45° FOV, color fundus photograph, NIDEK AFC-230 — 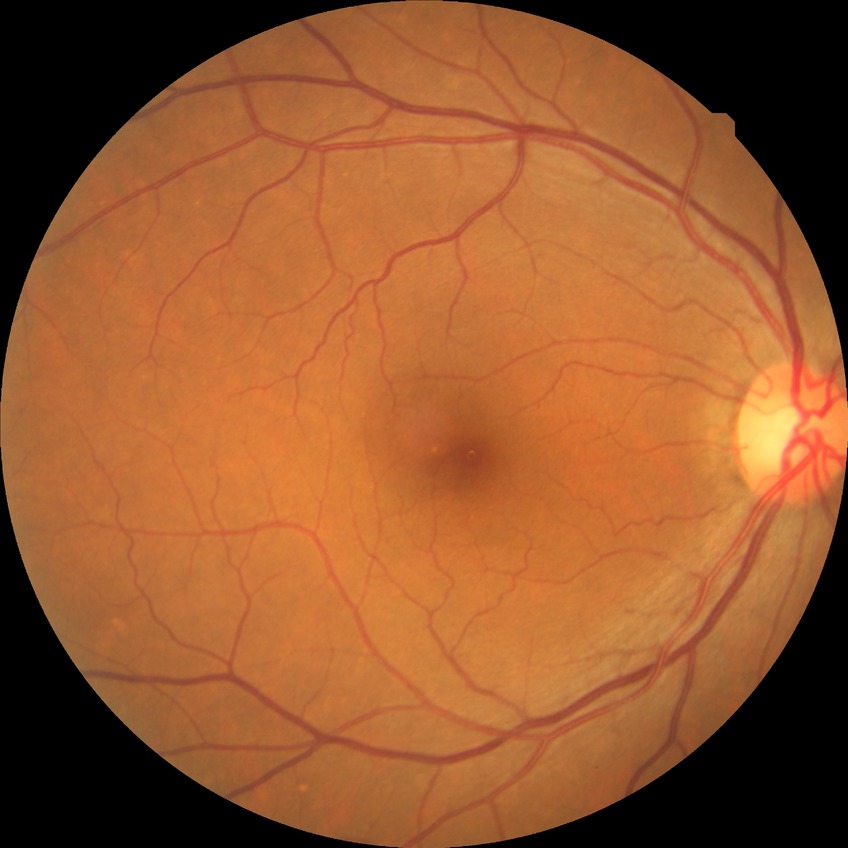
Diabetic retinopathy (DR): NDR (no diabetic retinopathy).